Portable fundus photograph:
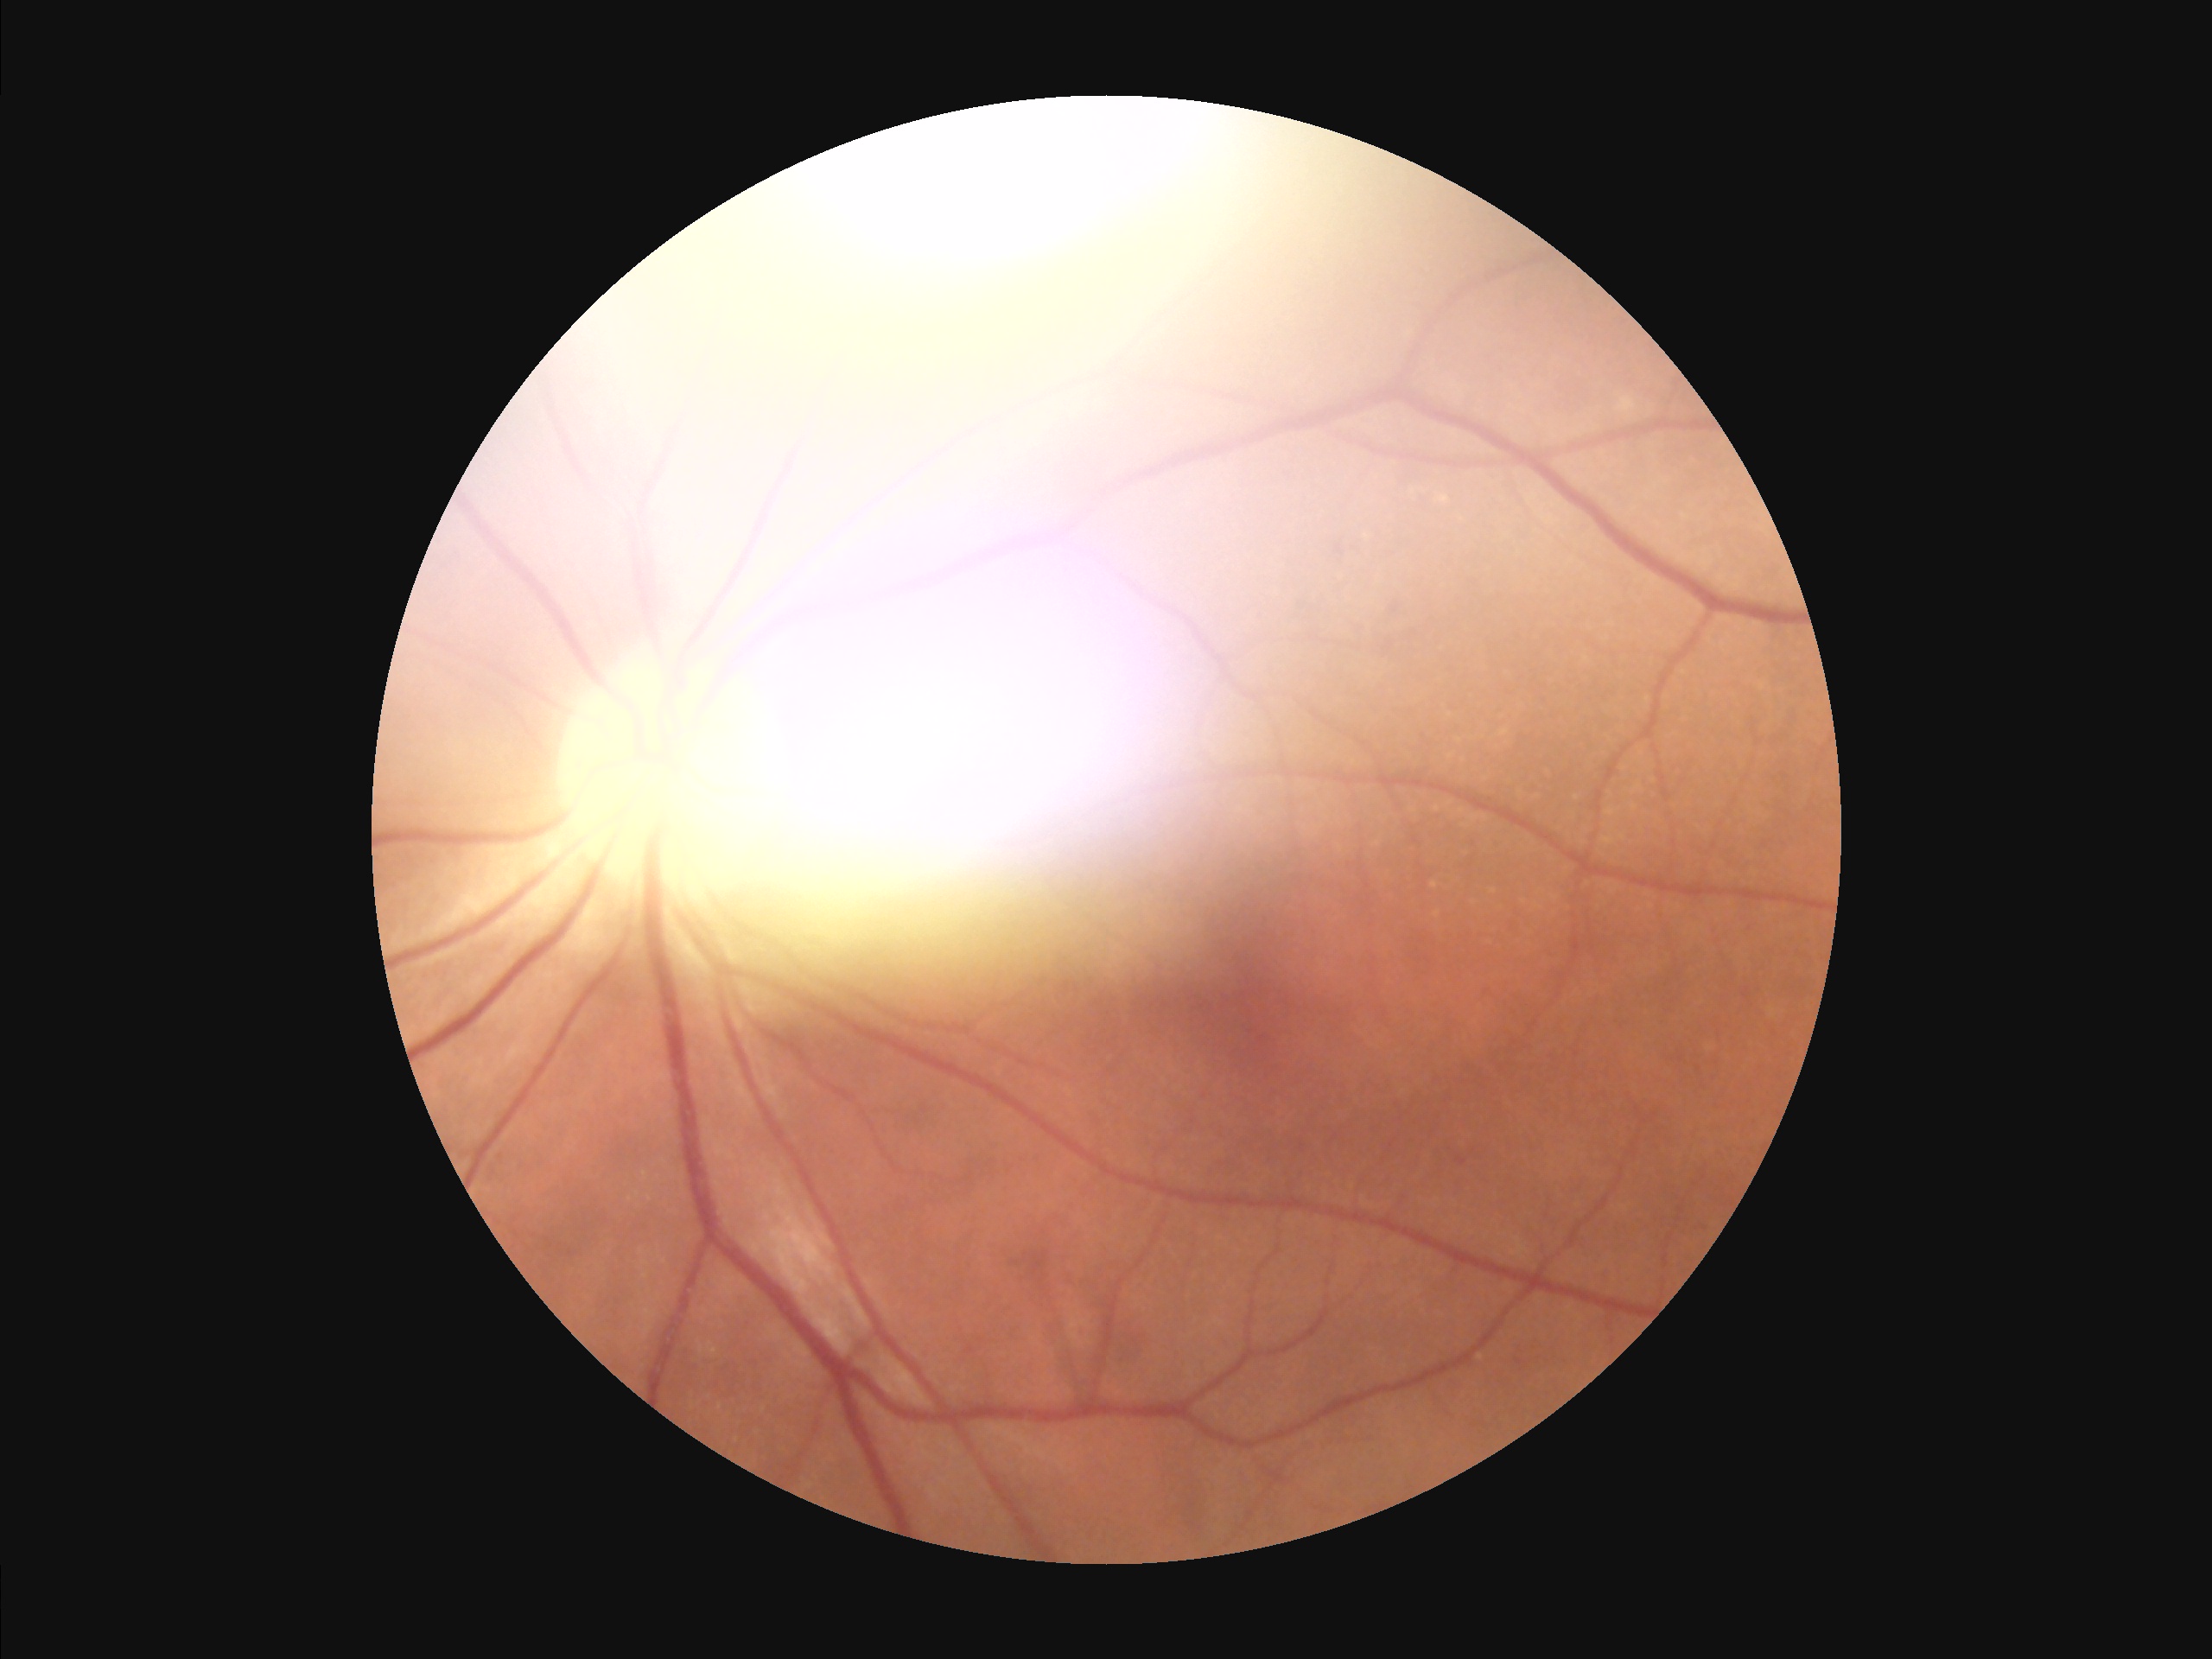
Image quality assessment: illumination/color: uneven; overall: suboptimal; focus: sharp; contrast: good.